Infant wide-field fundus photograph
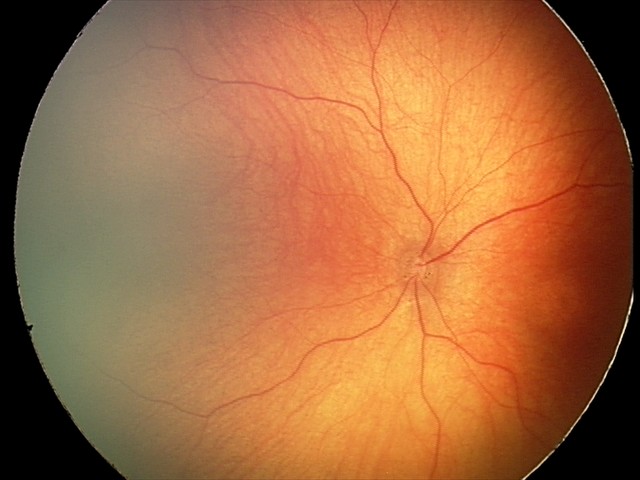 Screening series with optic nerve hypoplasia.